Pediatric wide-field fundus photograph
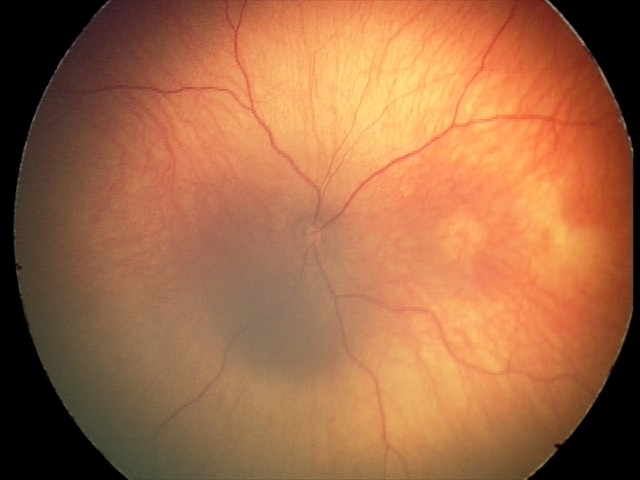

Diagnosis from this screening exam: optic nerve hypoplasia.